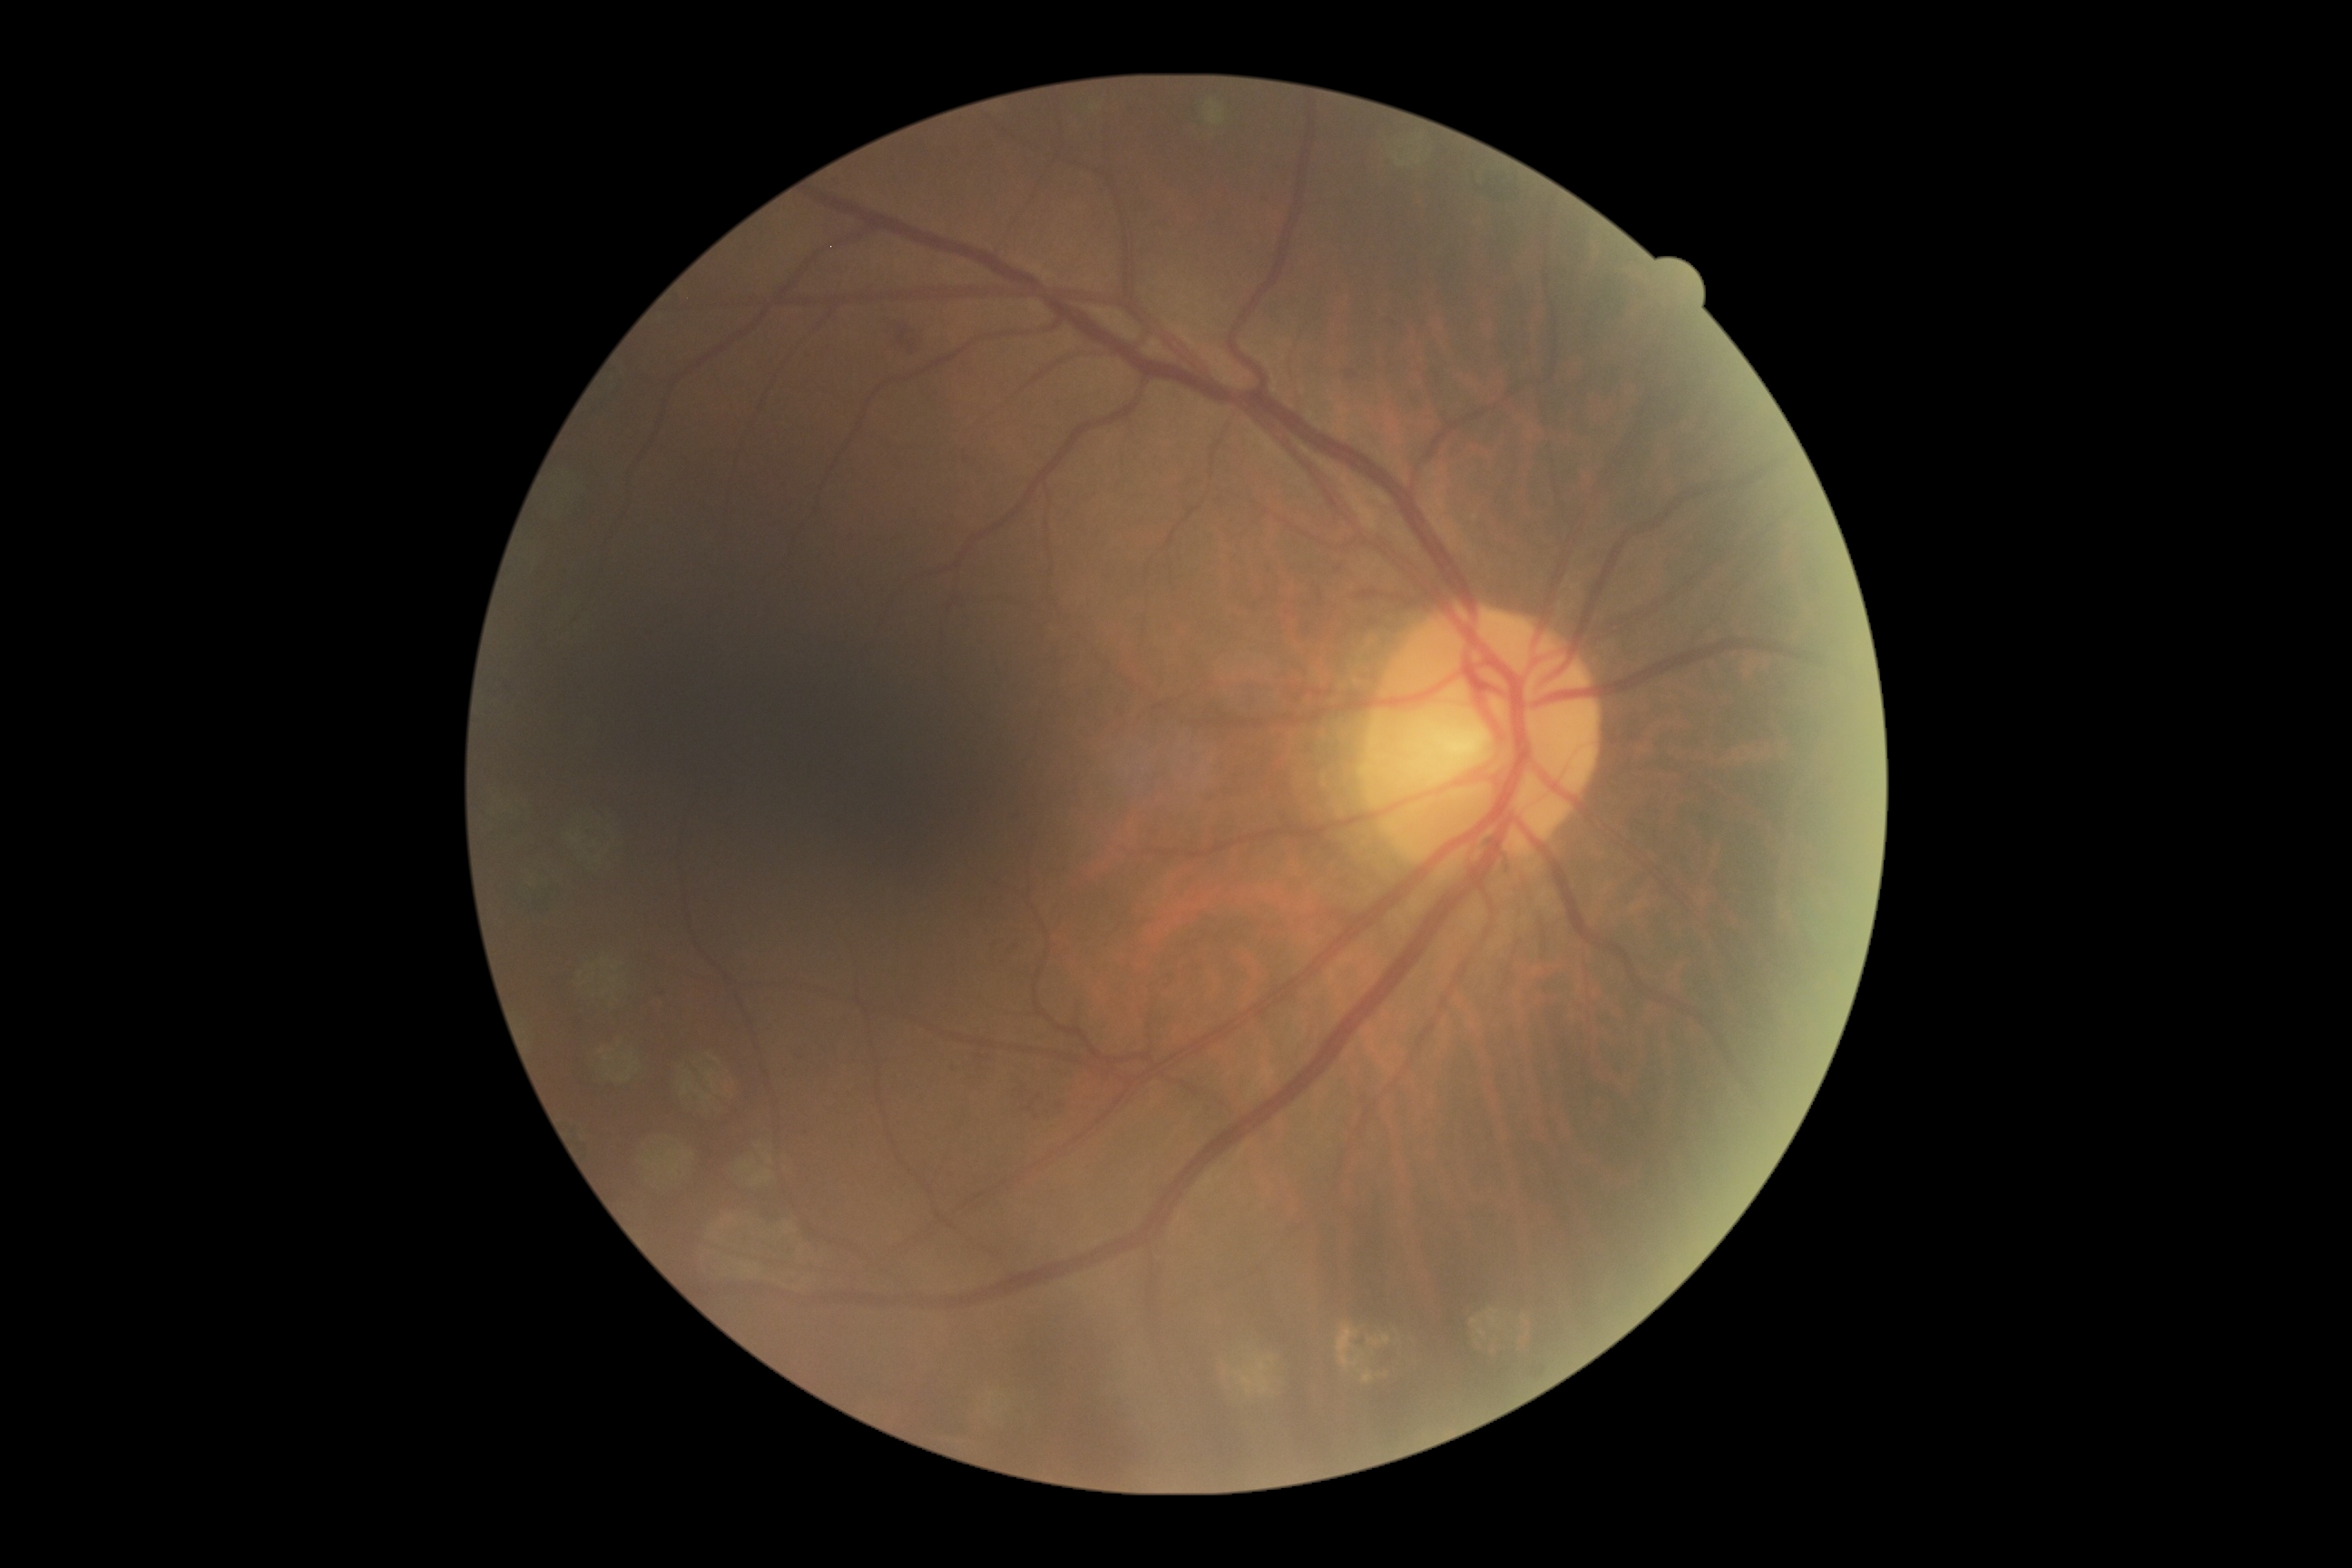

DR stage: moderate NPDR (grade 2). The retinopathy is classified as non-proliferative diabetic retinopathy.